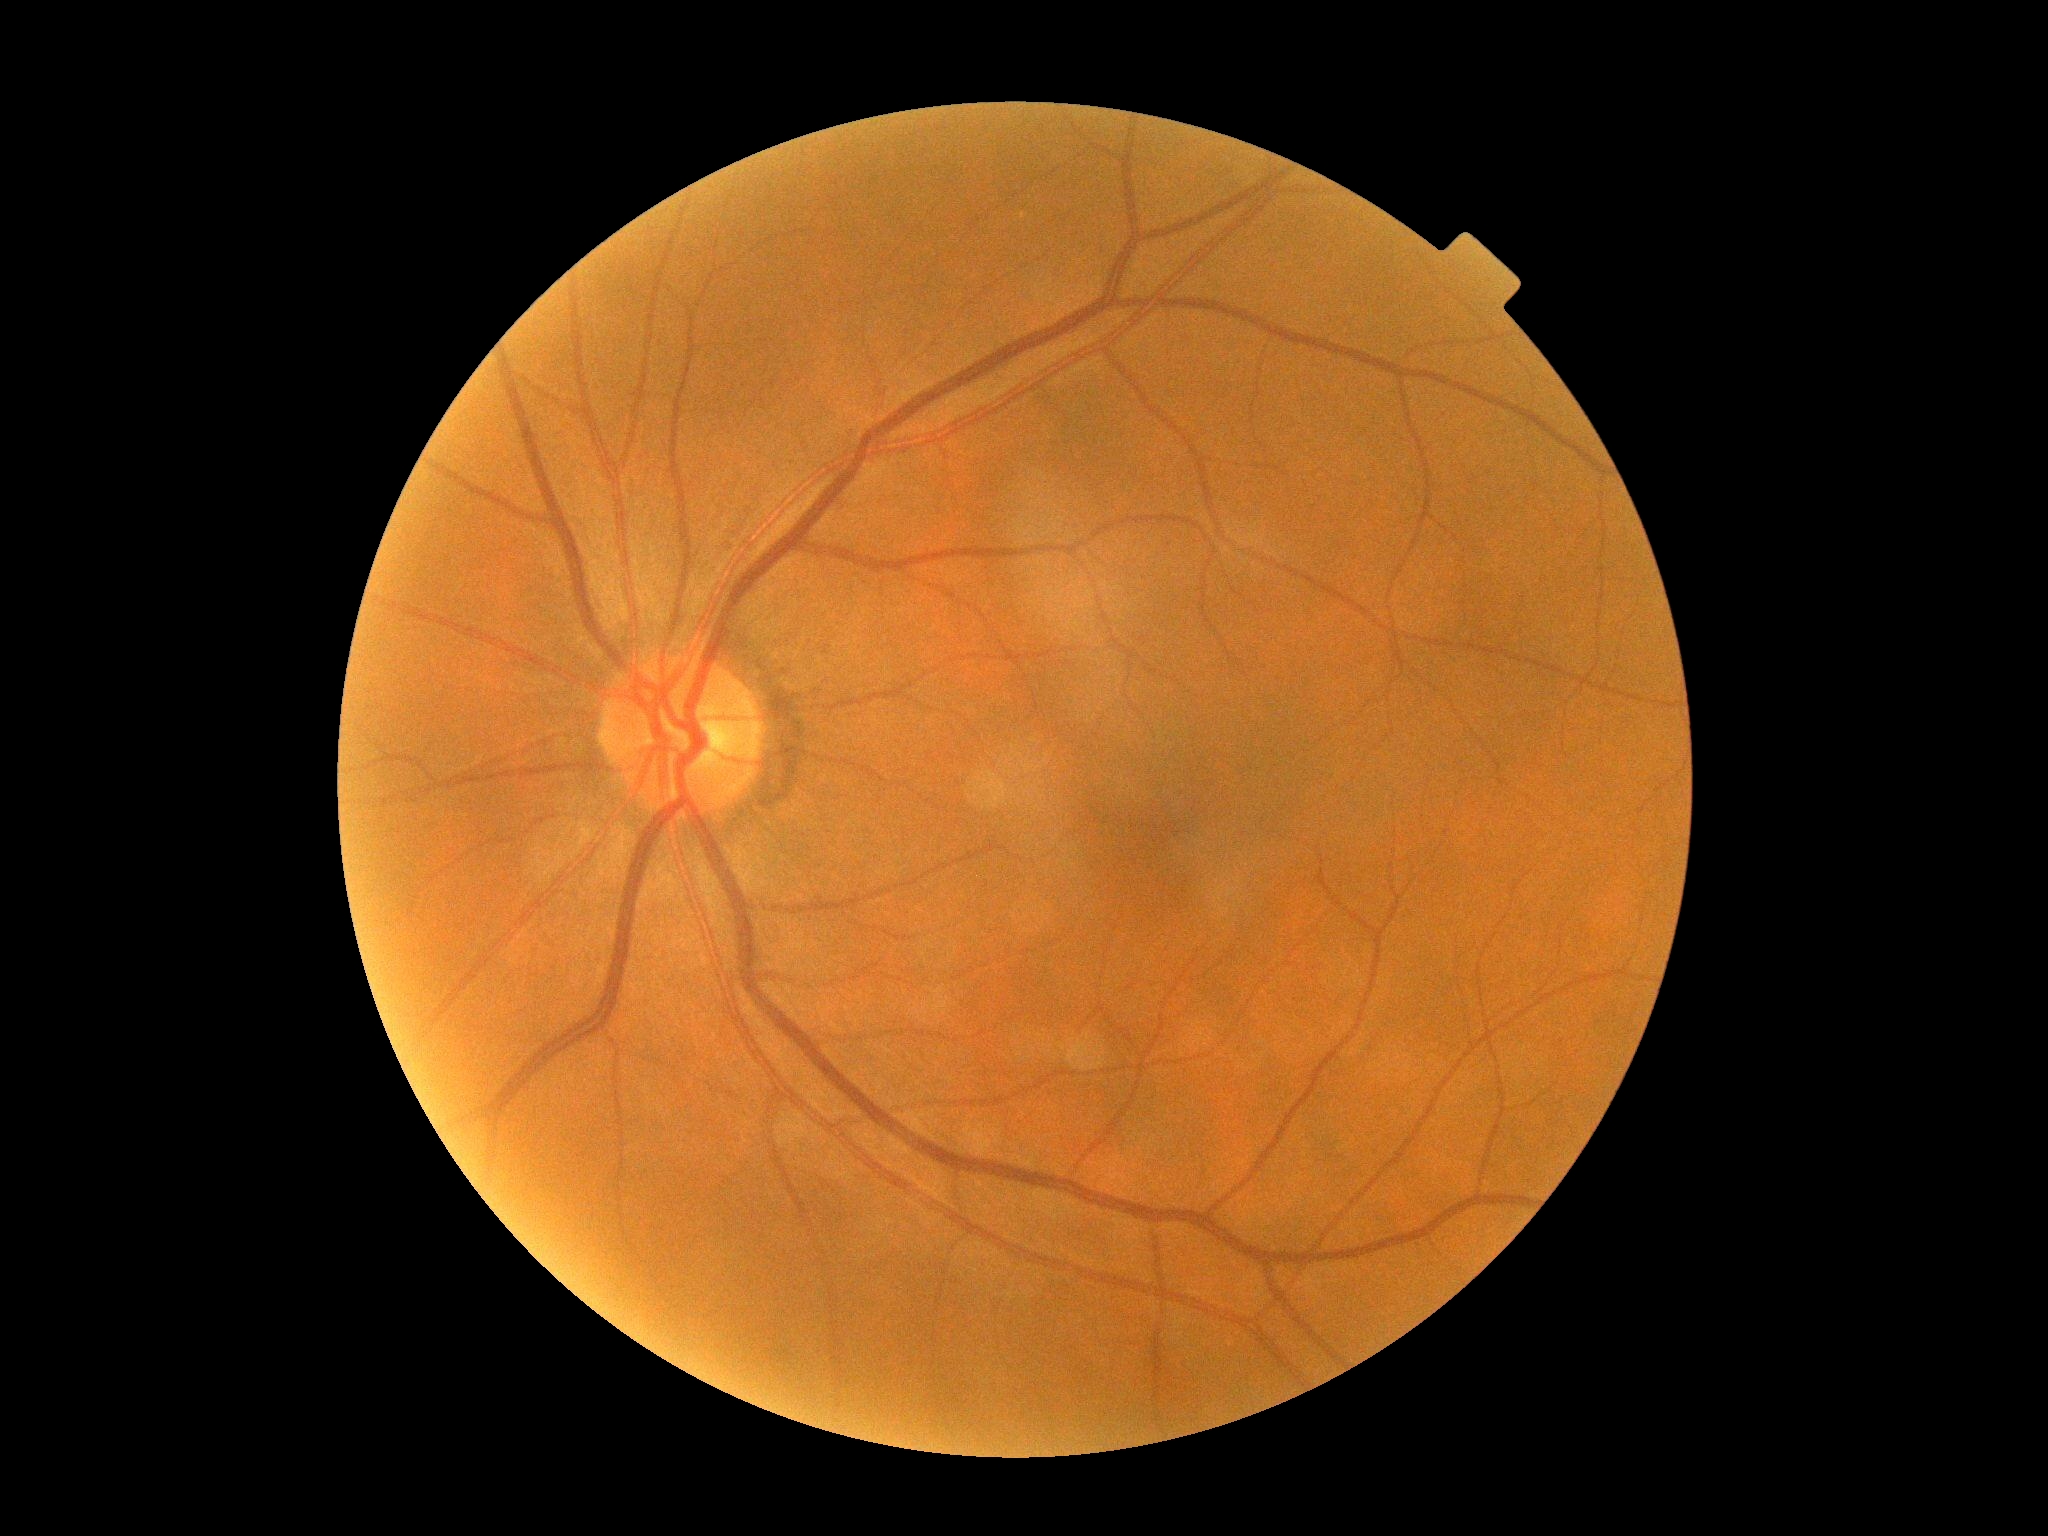
Retinopathy grade is 0/4 — no visible signs of diabetic retinopathy.